Image size 1932x1932 · retinal fundus photograph · 45° FOV
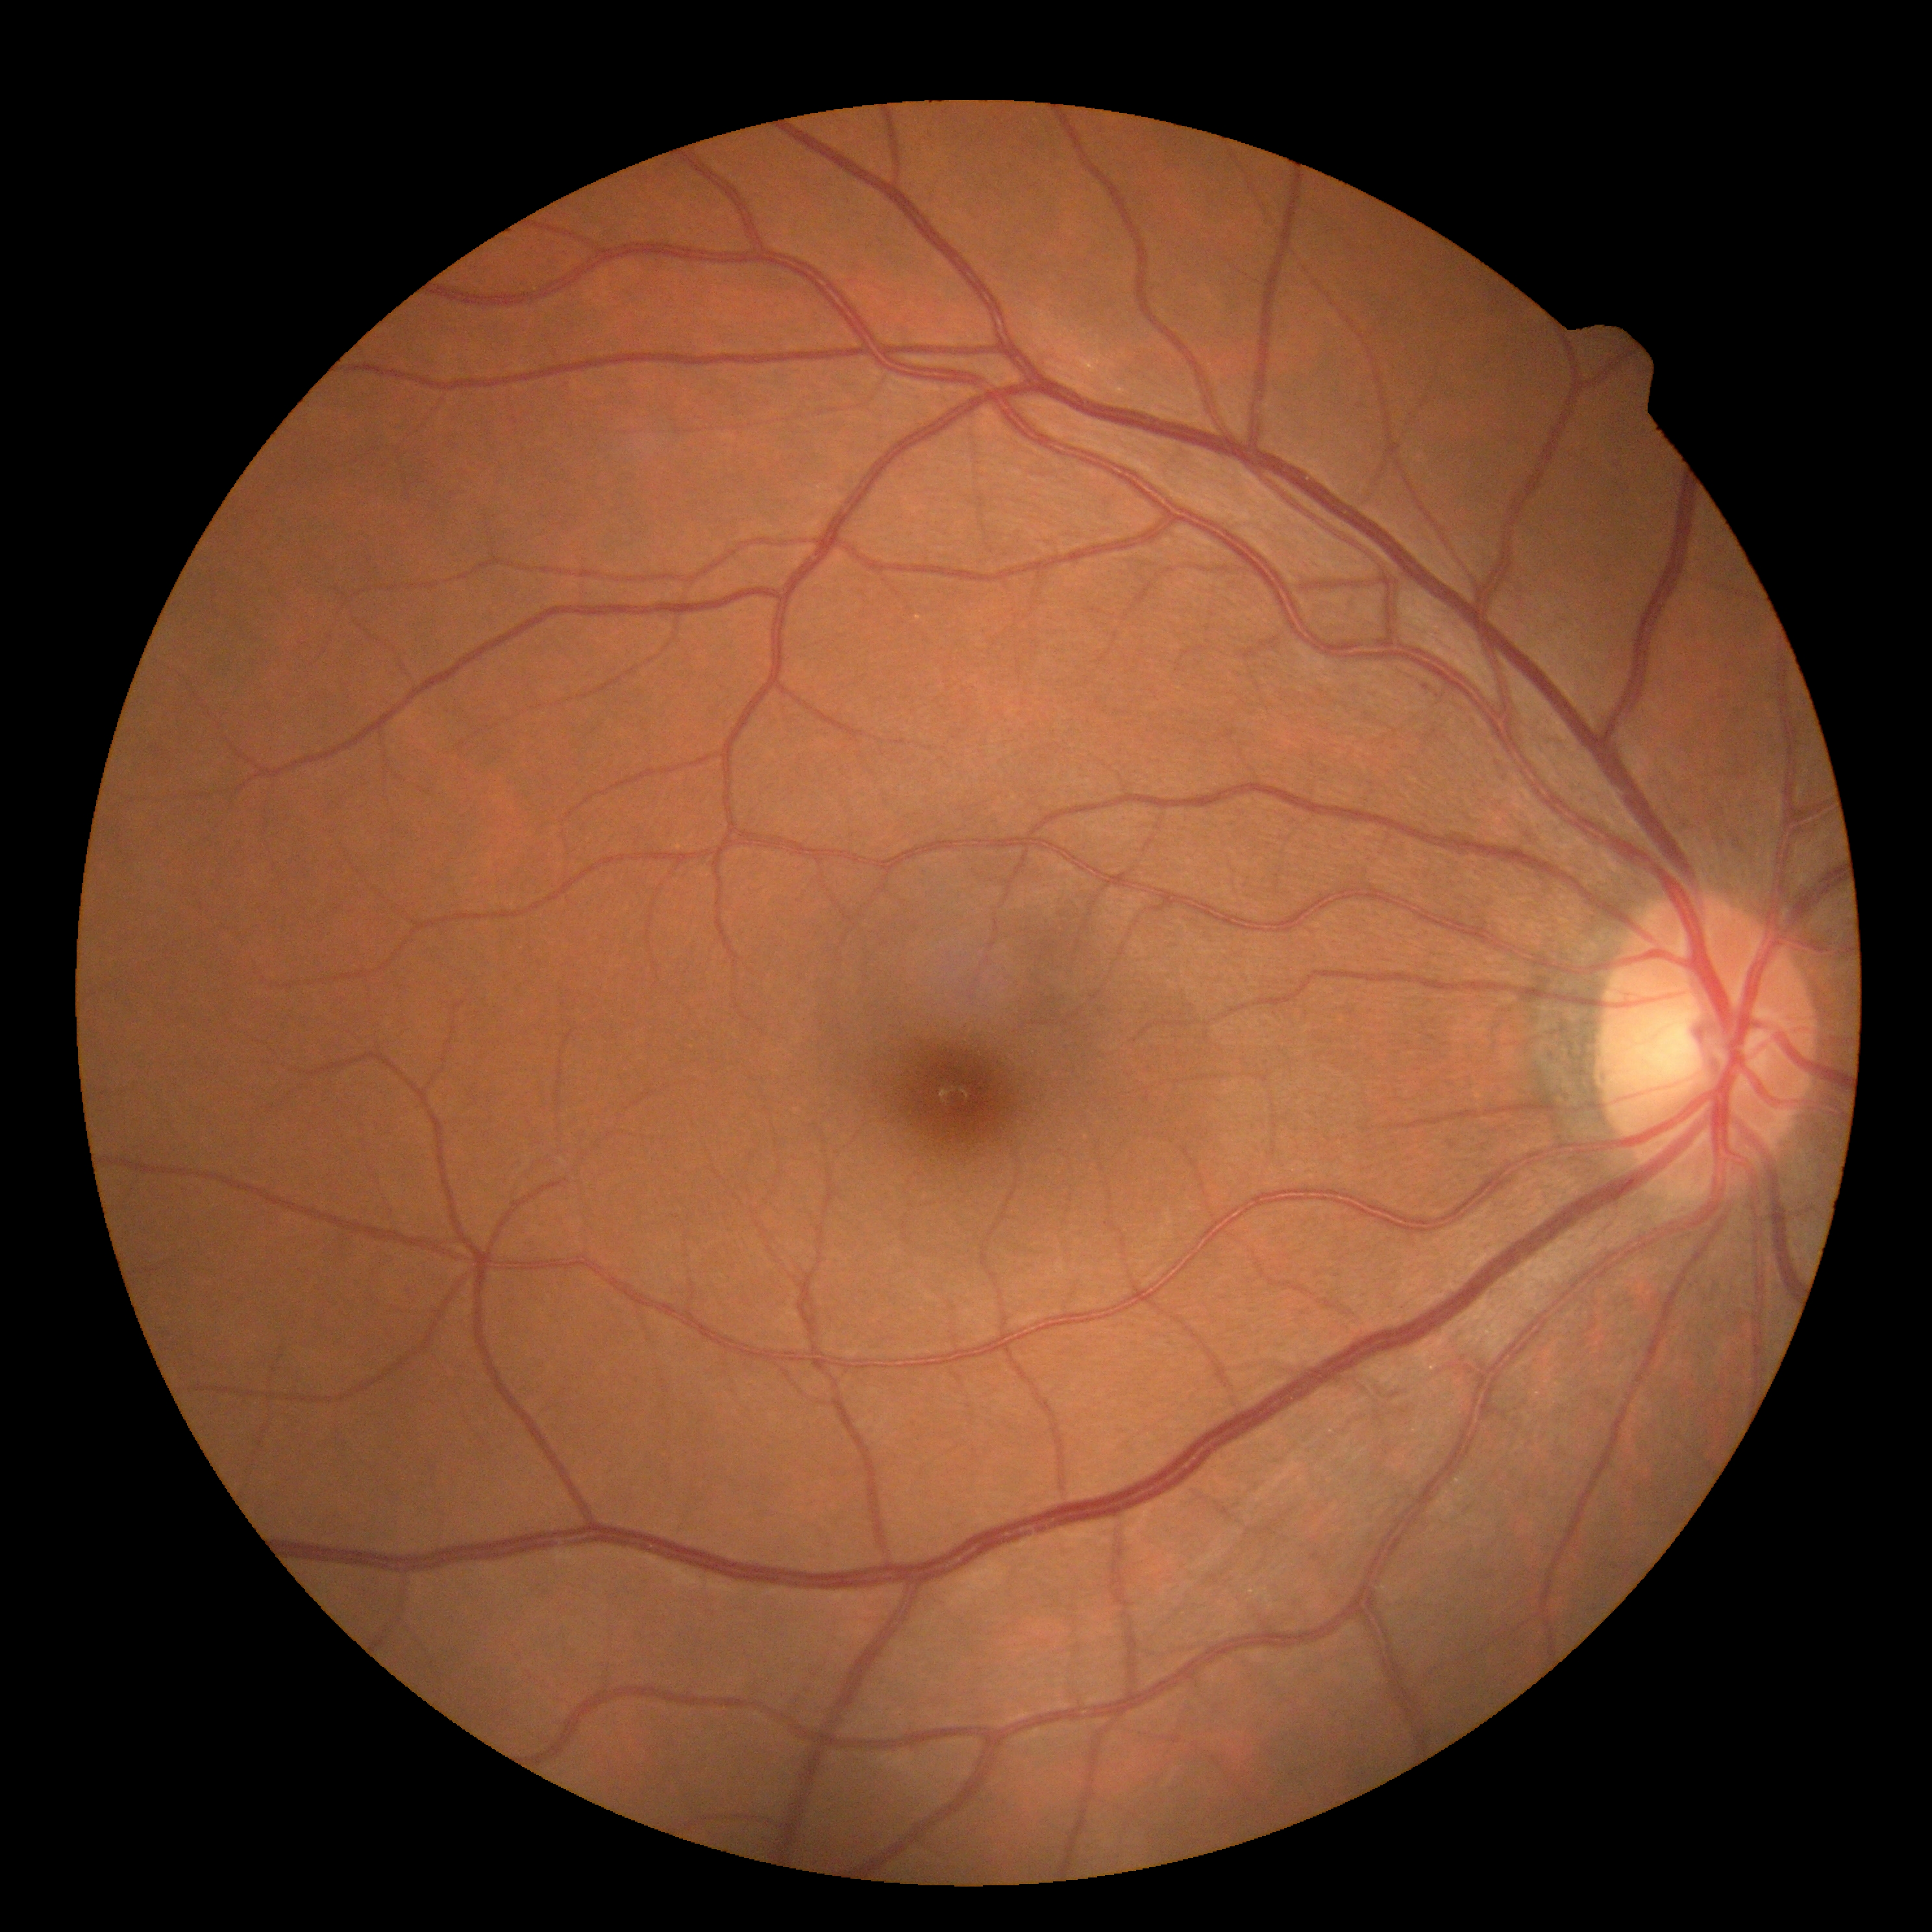

No apparent diabetic retinopathy. Diabetic retinopathy (DR) is no apparent retinopathy (grade 0) — no visible signs of diabetic retinopathy.